2352 x 1568 pixels; 45-degree field of view — 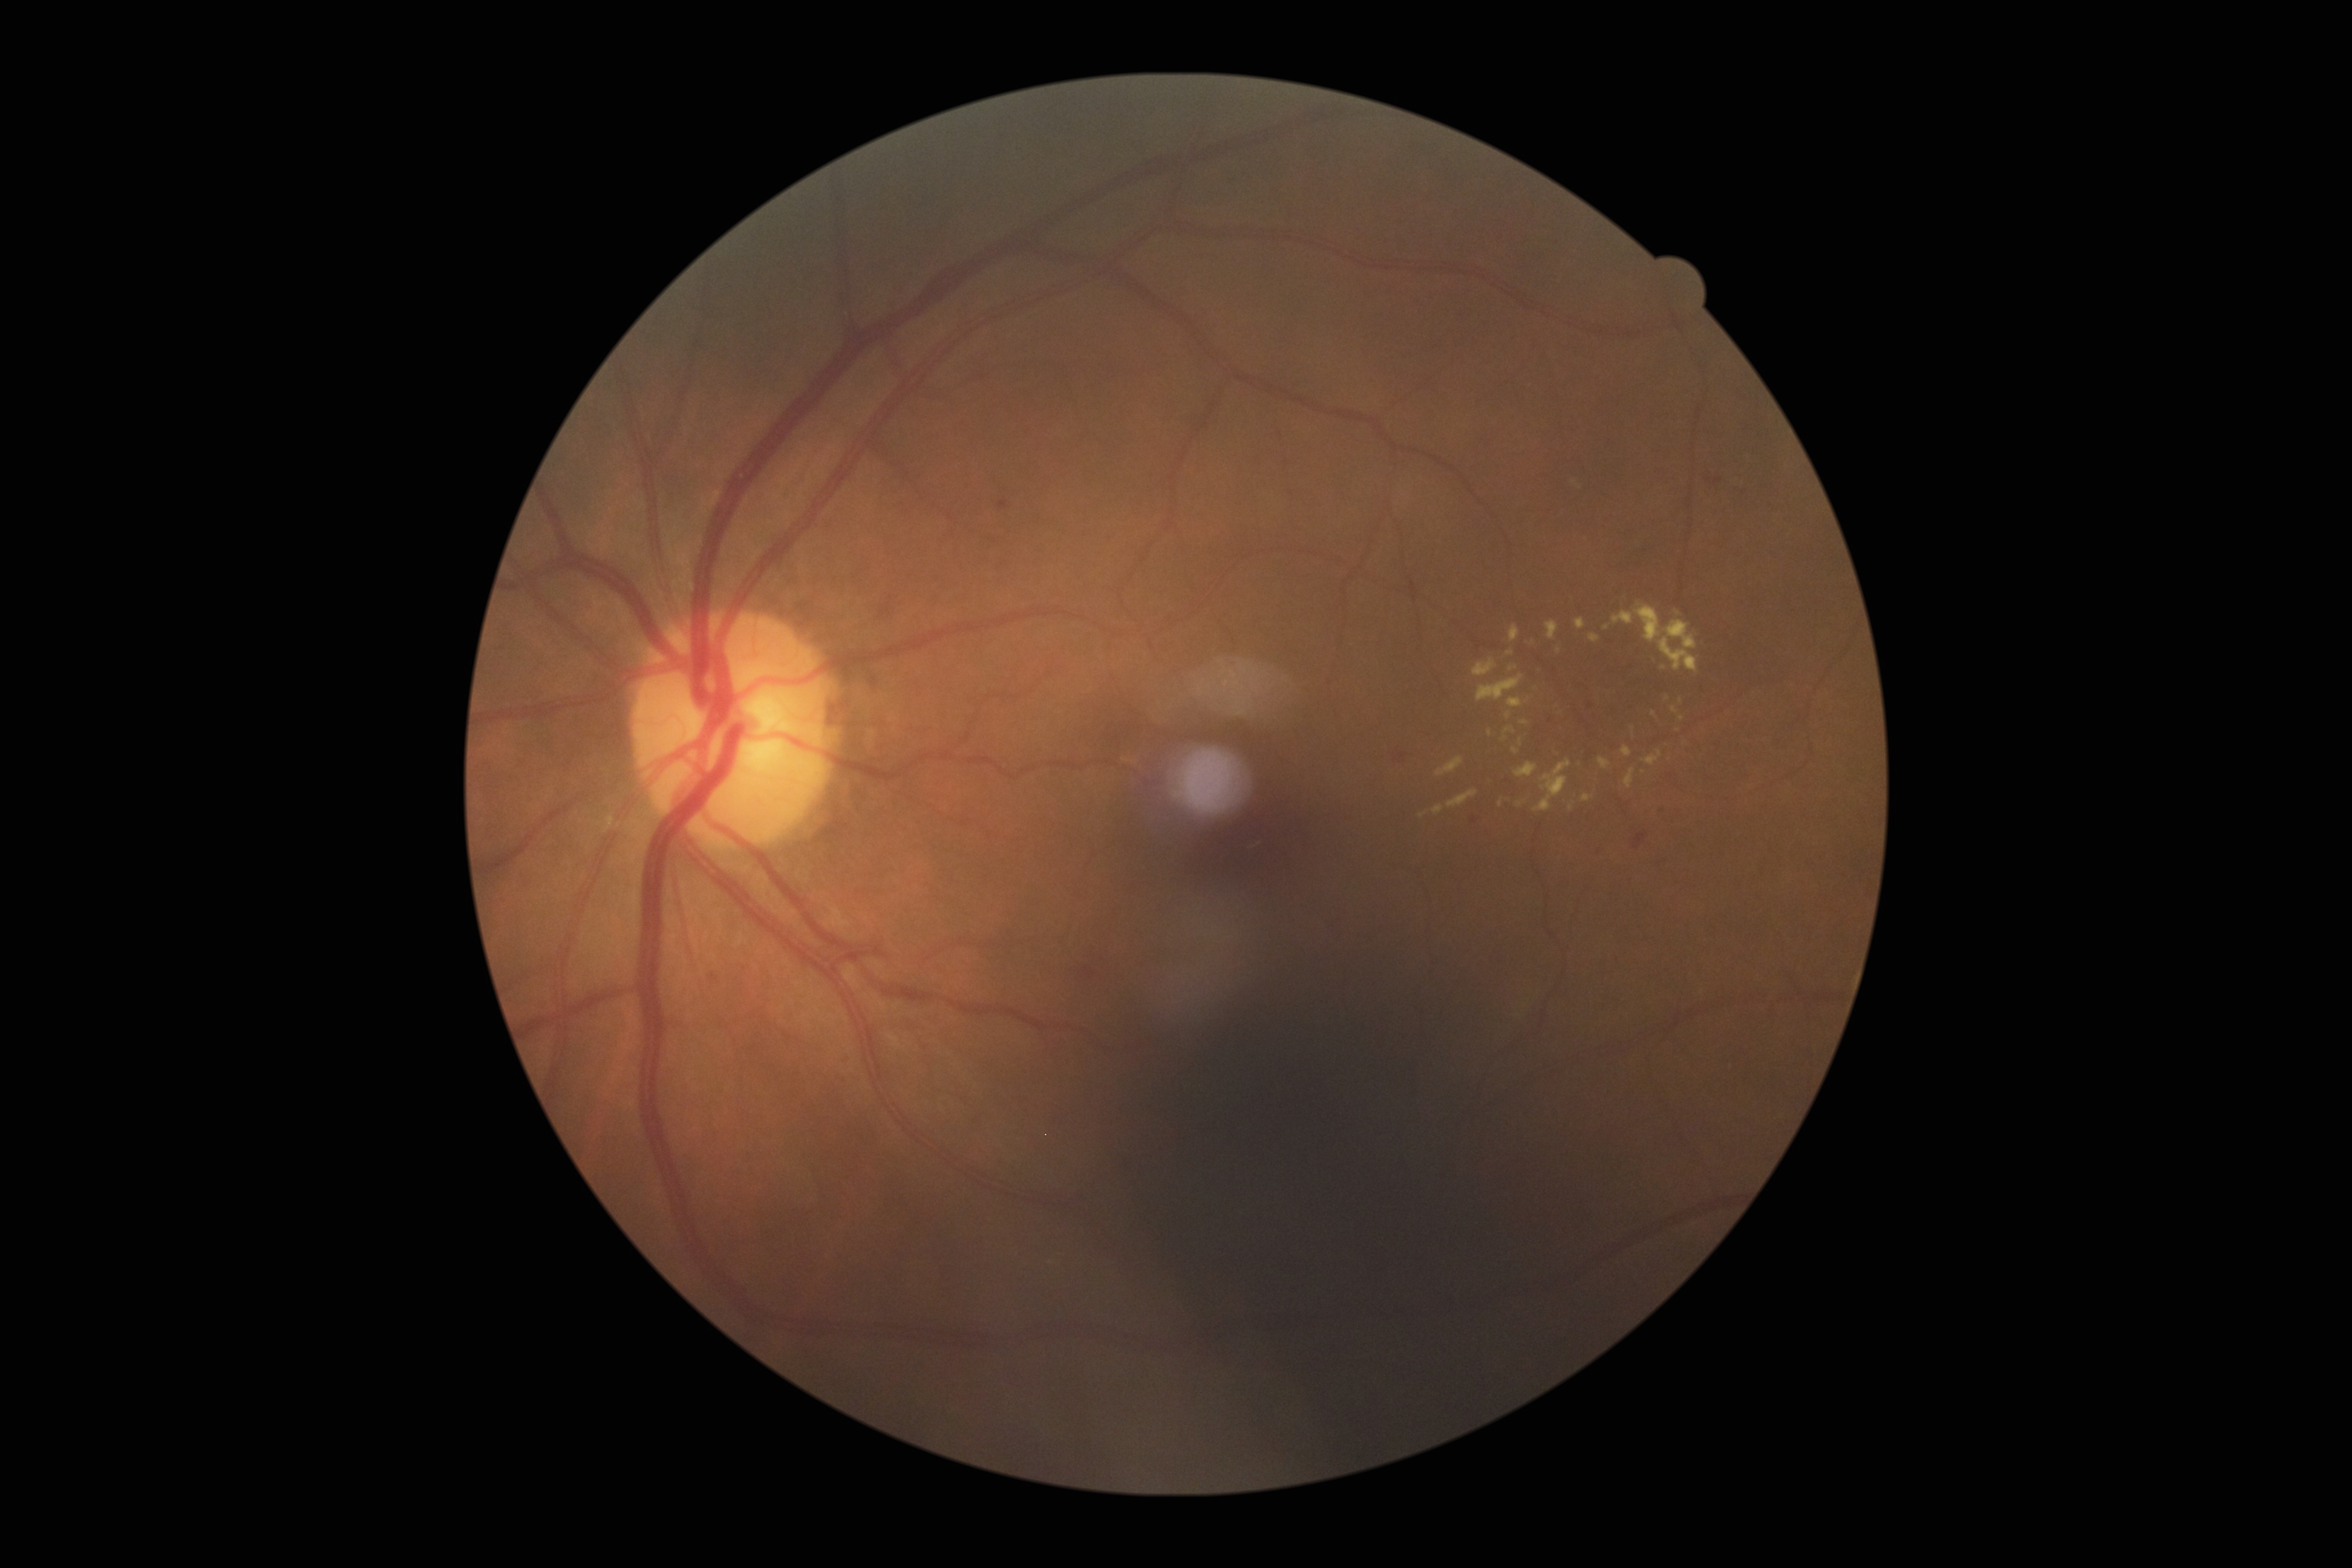
Annotations:
* diabetic retinopathy — grade 2 (moderate NPDR)